Infant wide-field fundus photograph · captured with the Clarity RetCam 3 (130° field of view)
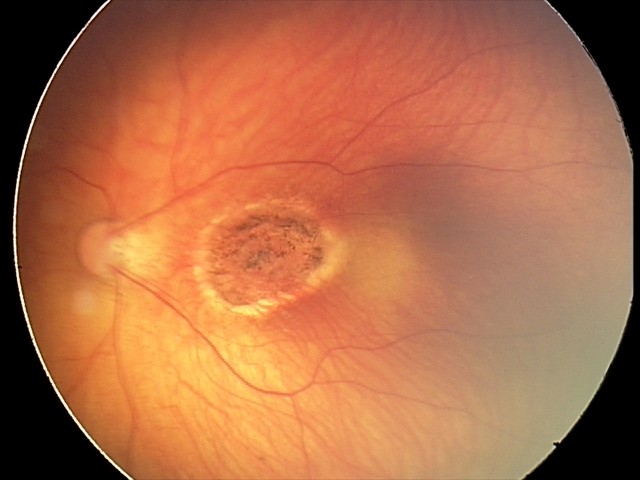

Finding: toxoplasmosis chorioretinitis.